Graded on the modified Davis scale, without pupil dilation.
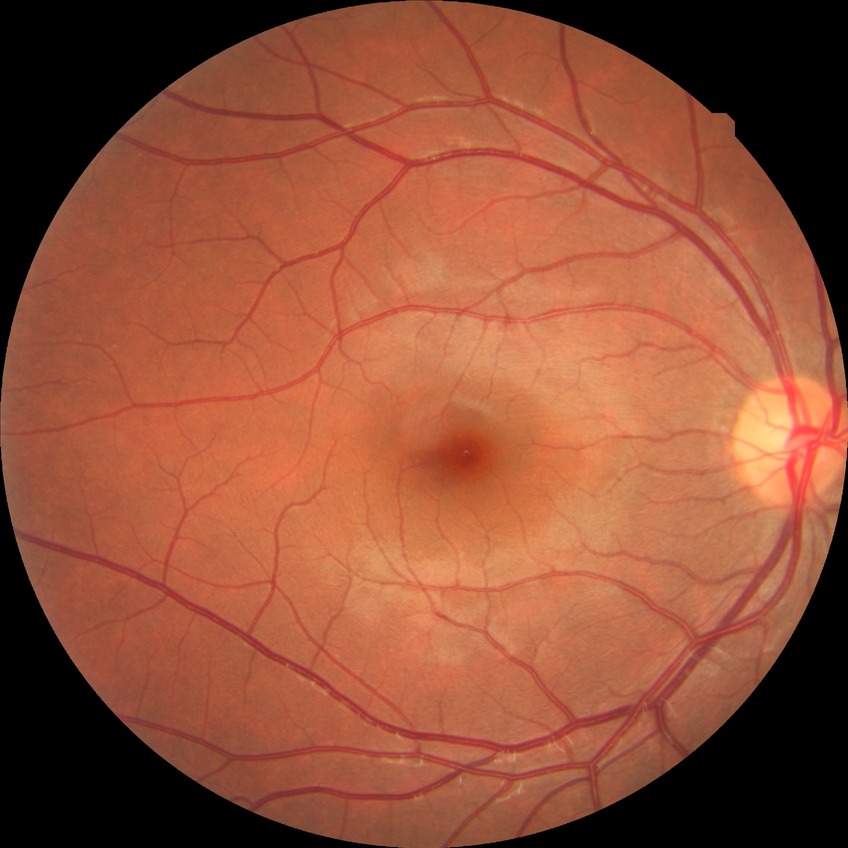

diabetic retinopathy (DR): NDR (no diabetic retinopathy)